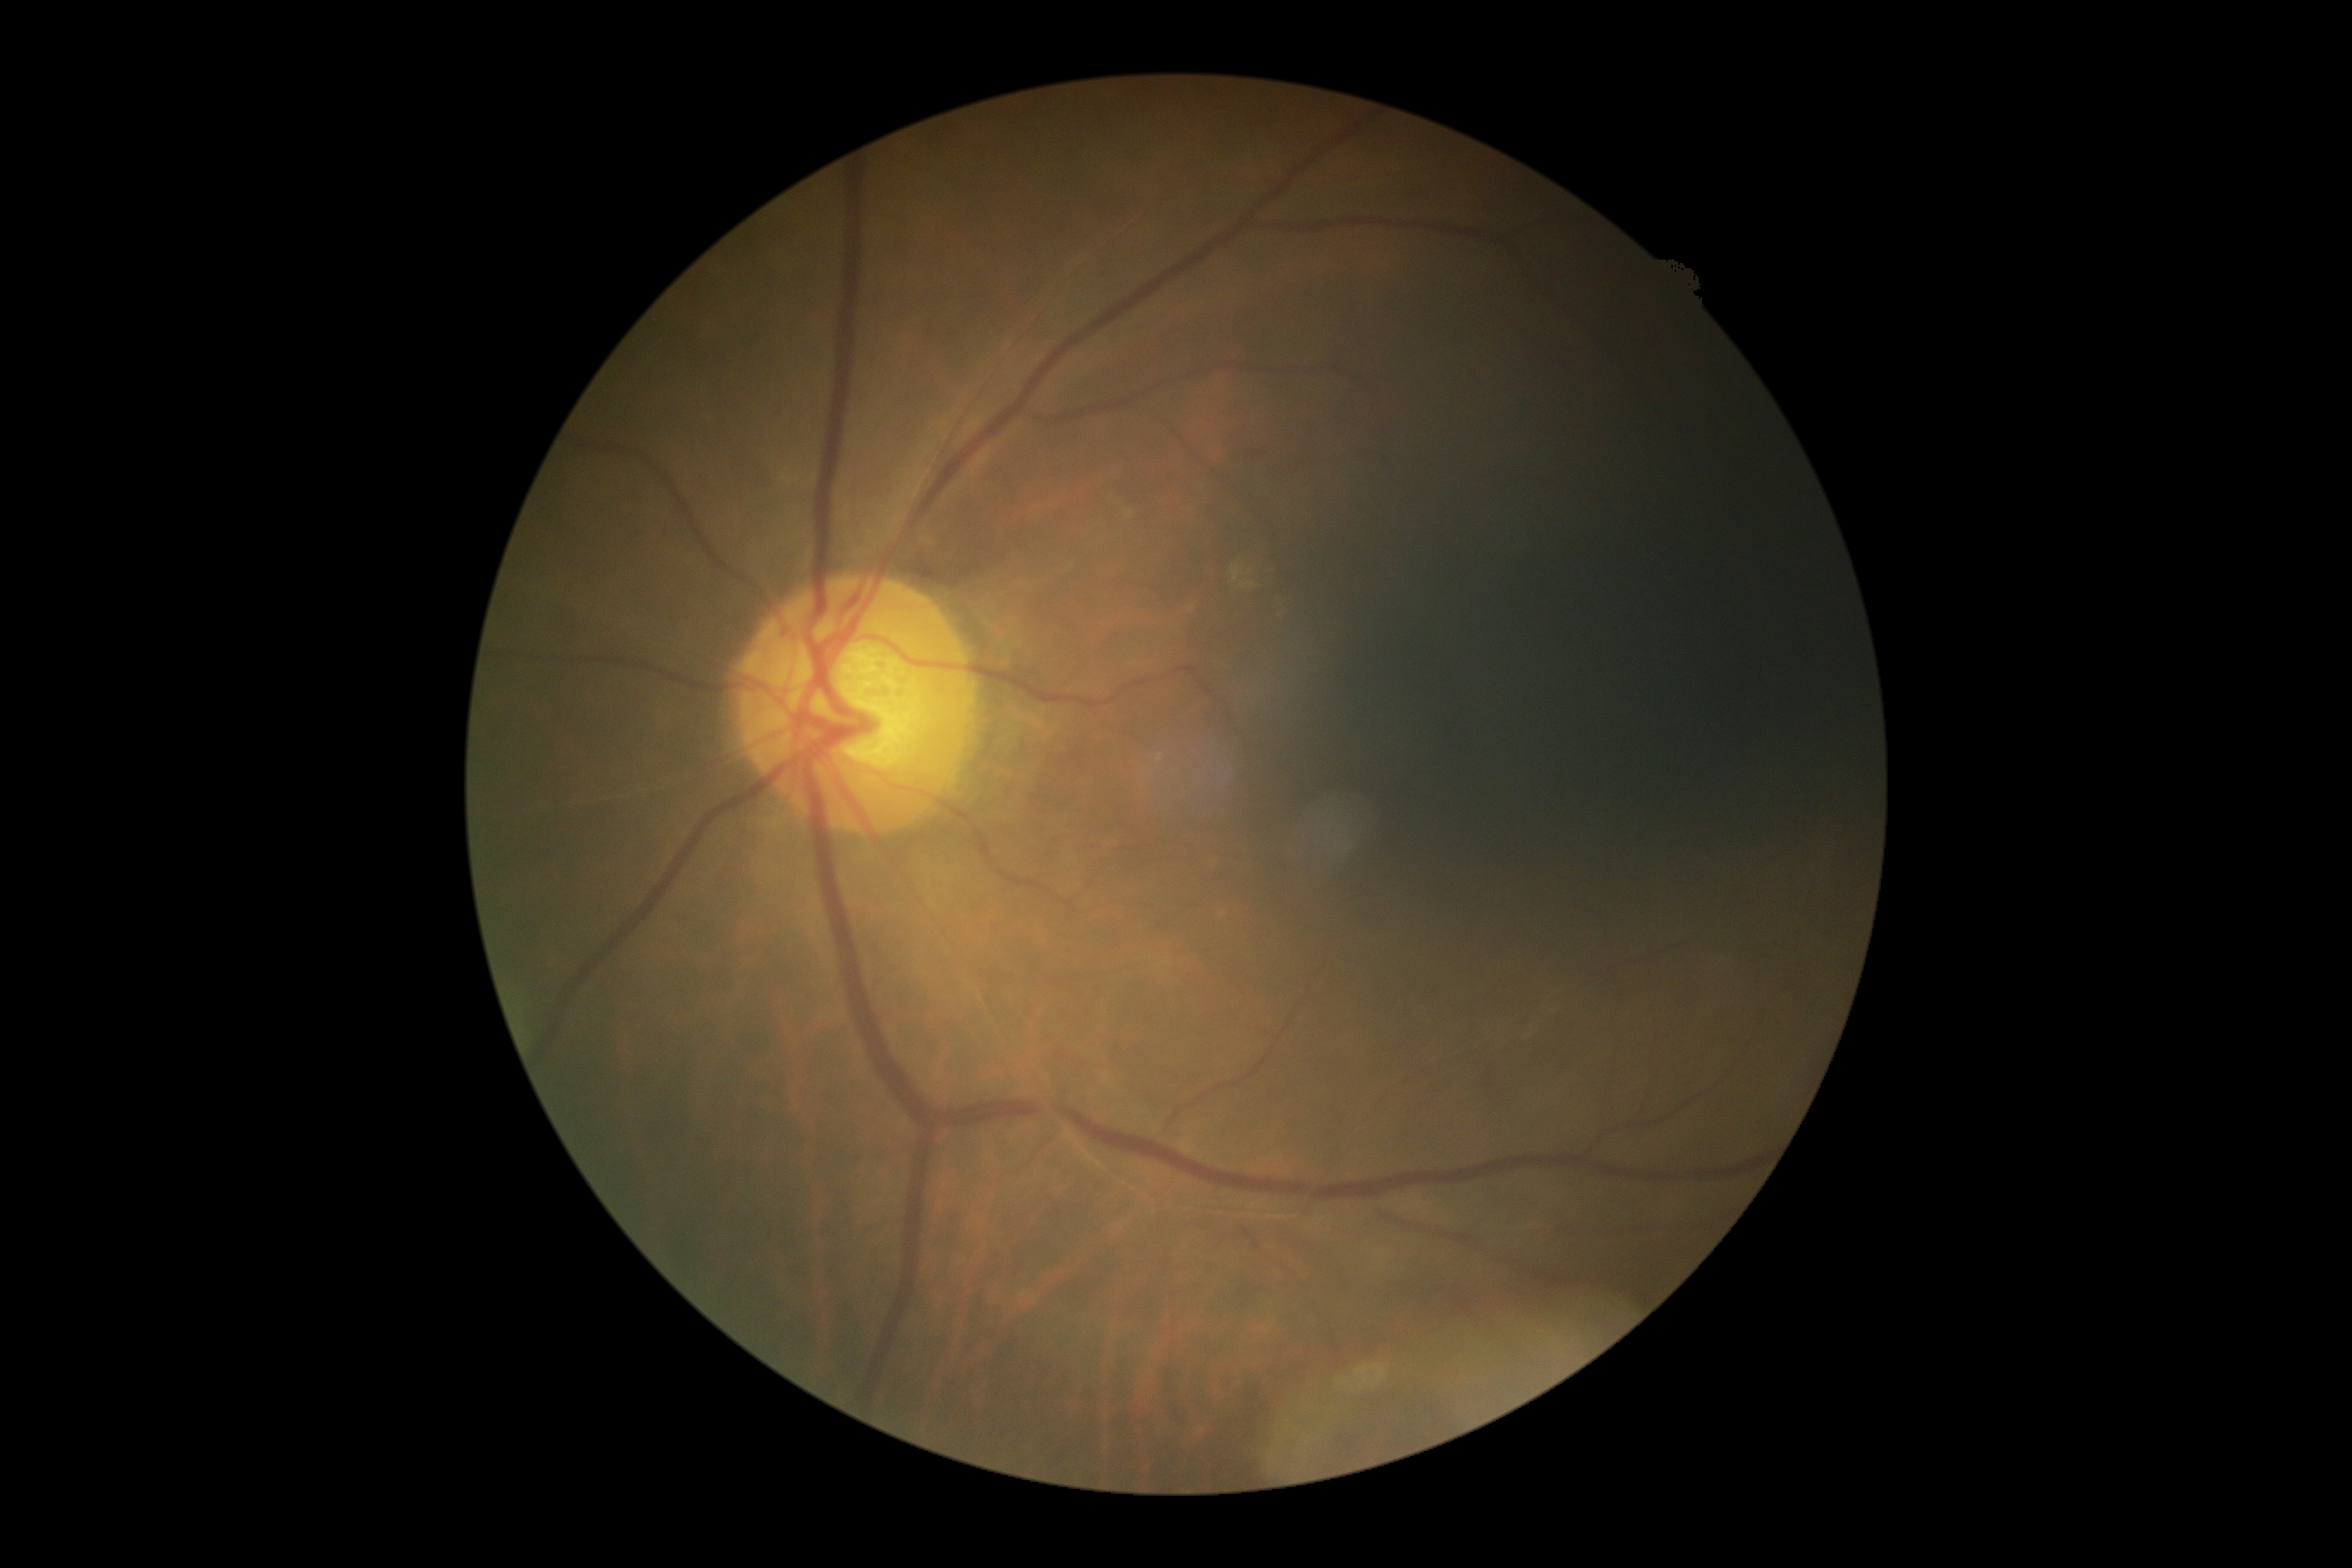
DR severity is 1.